640x480px · infant wide-field retinal image: 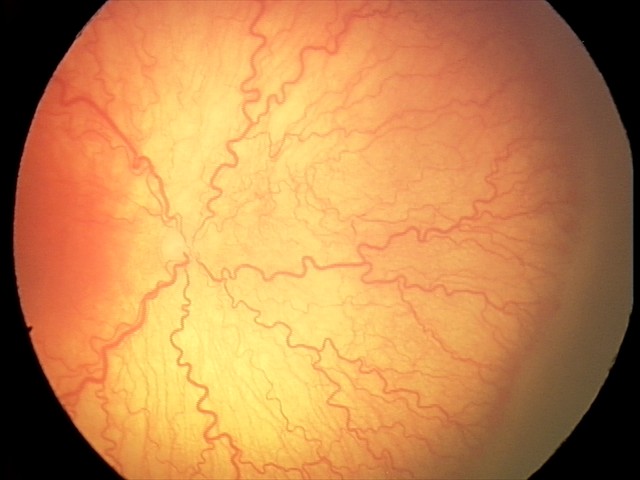 With plus disease.
Series diagnosed as aggressive retinopathy of prematurity.